Camera: Clarity RetCam 3 (130° FOV) · 640x480 · wide-field fundus photograph of an infant: 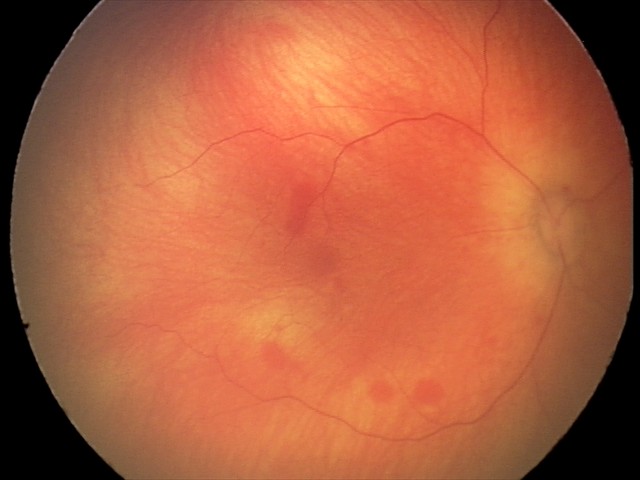
Diagnosis from this screening exam: retinal hemorrhages.